Wide-field fundus photograph from neonatal ROP screening; 640 x 480 pixels:
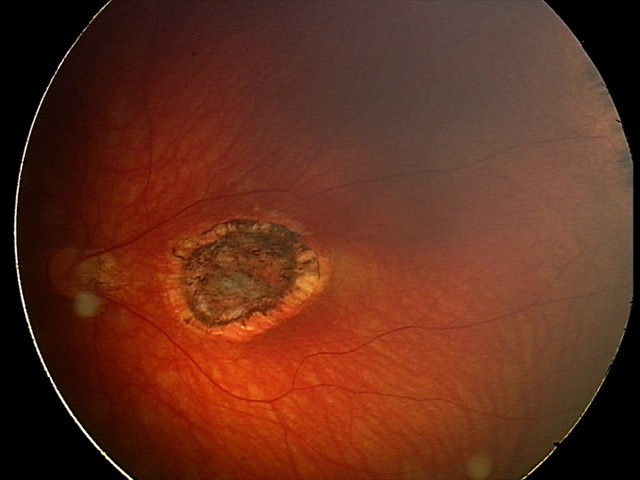 Q: What was the screening finding?
A: toxoplasmosis chorioretinitis